RetCam wide-field infant fundus image — 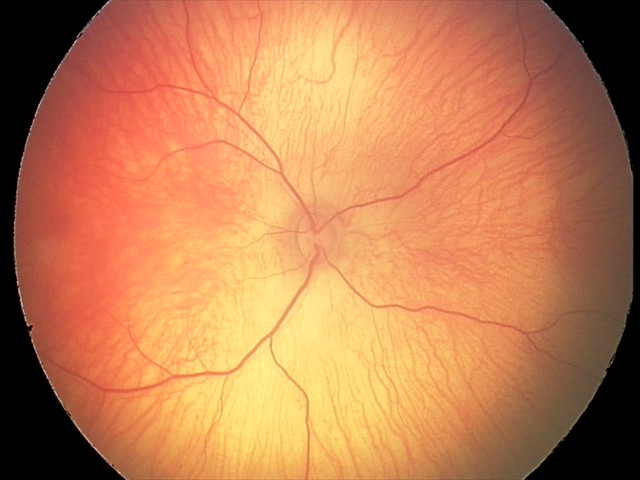

No retinal pathology identified on screening.